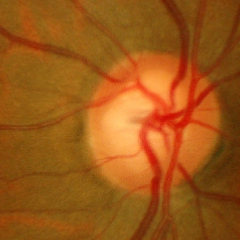

Optic disc photograph demonstrating early glaucomatous changes. (Criteria: glaucomatous retinal nerve fiber layer defects on red-free fundus photography without visual field defects.)